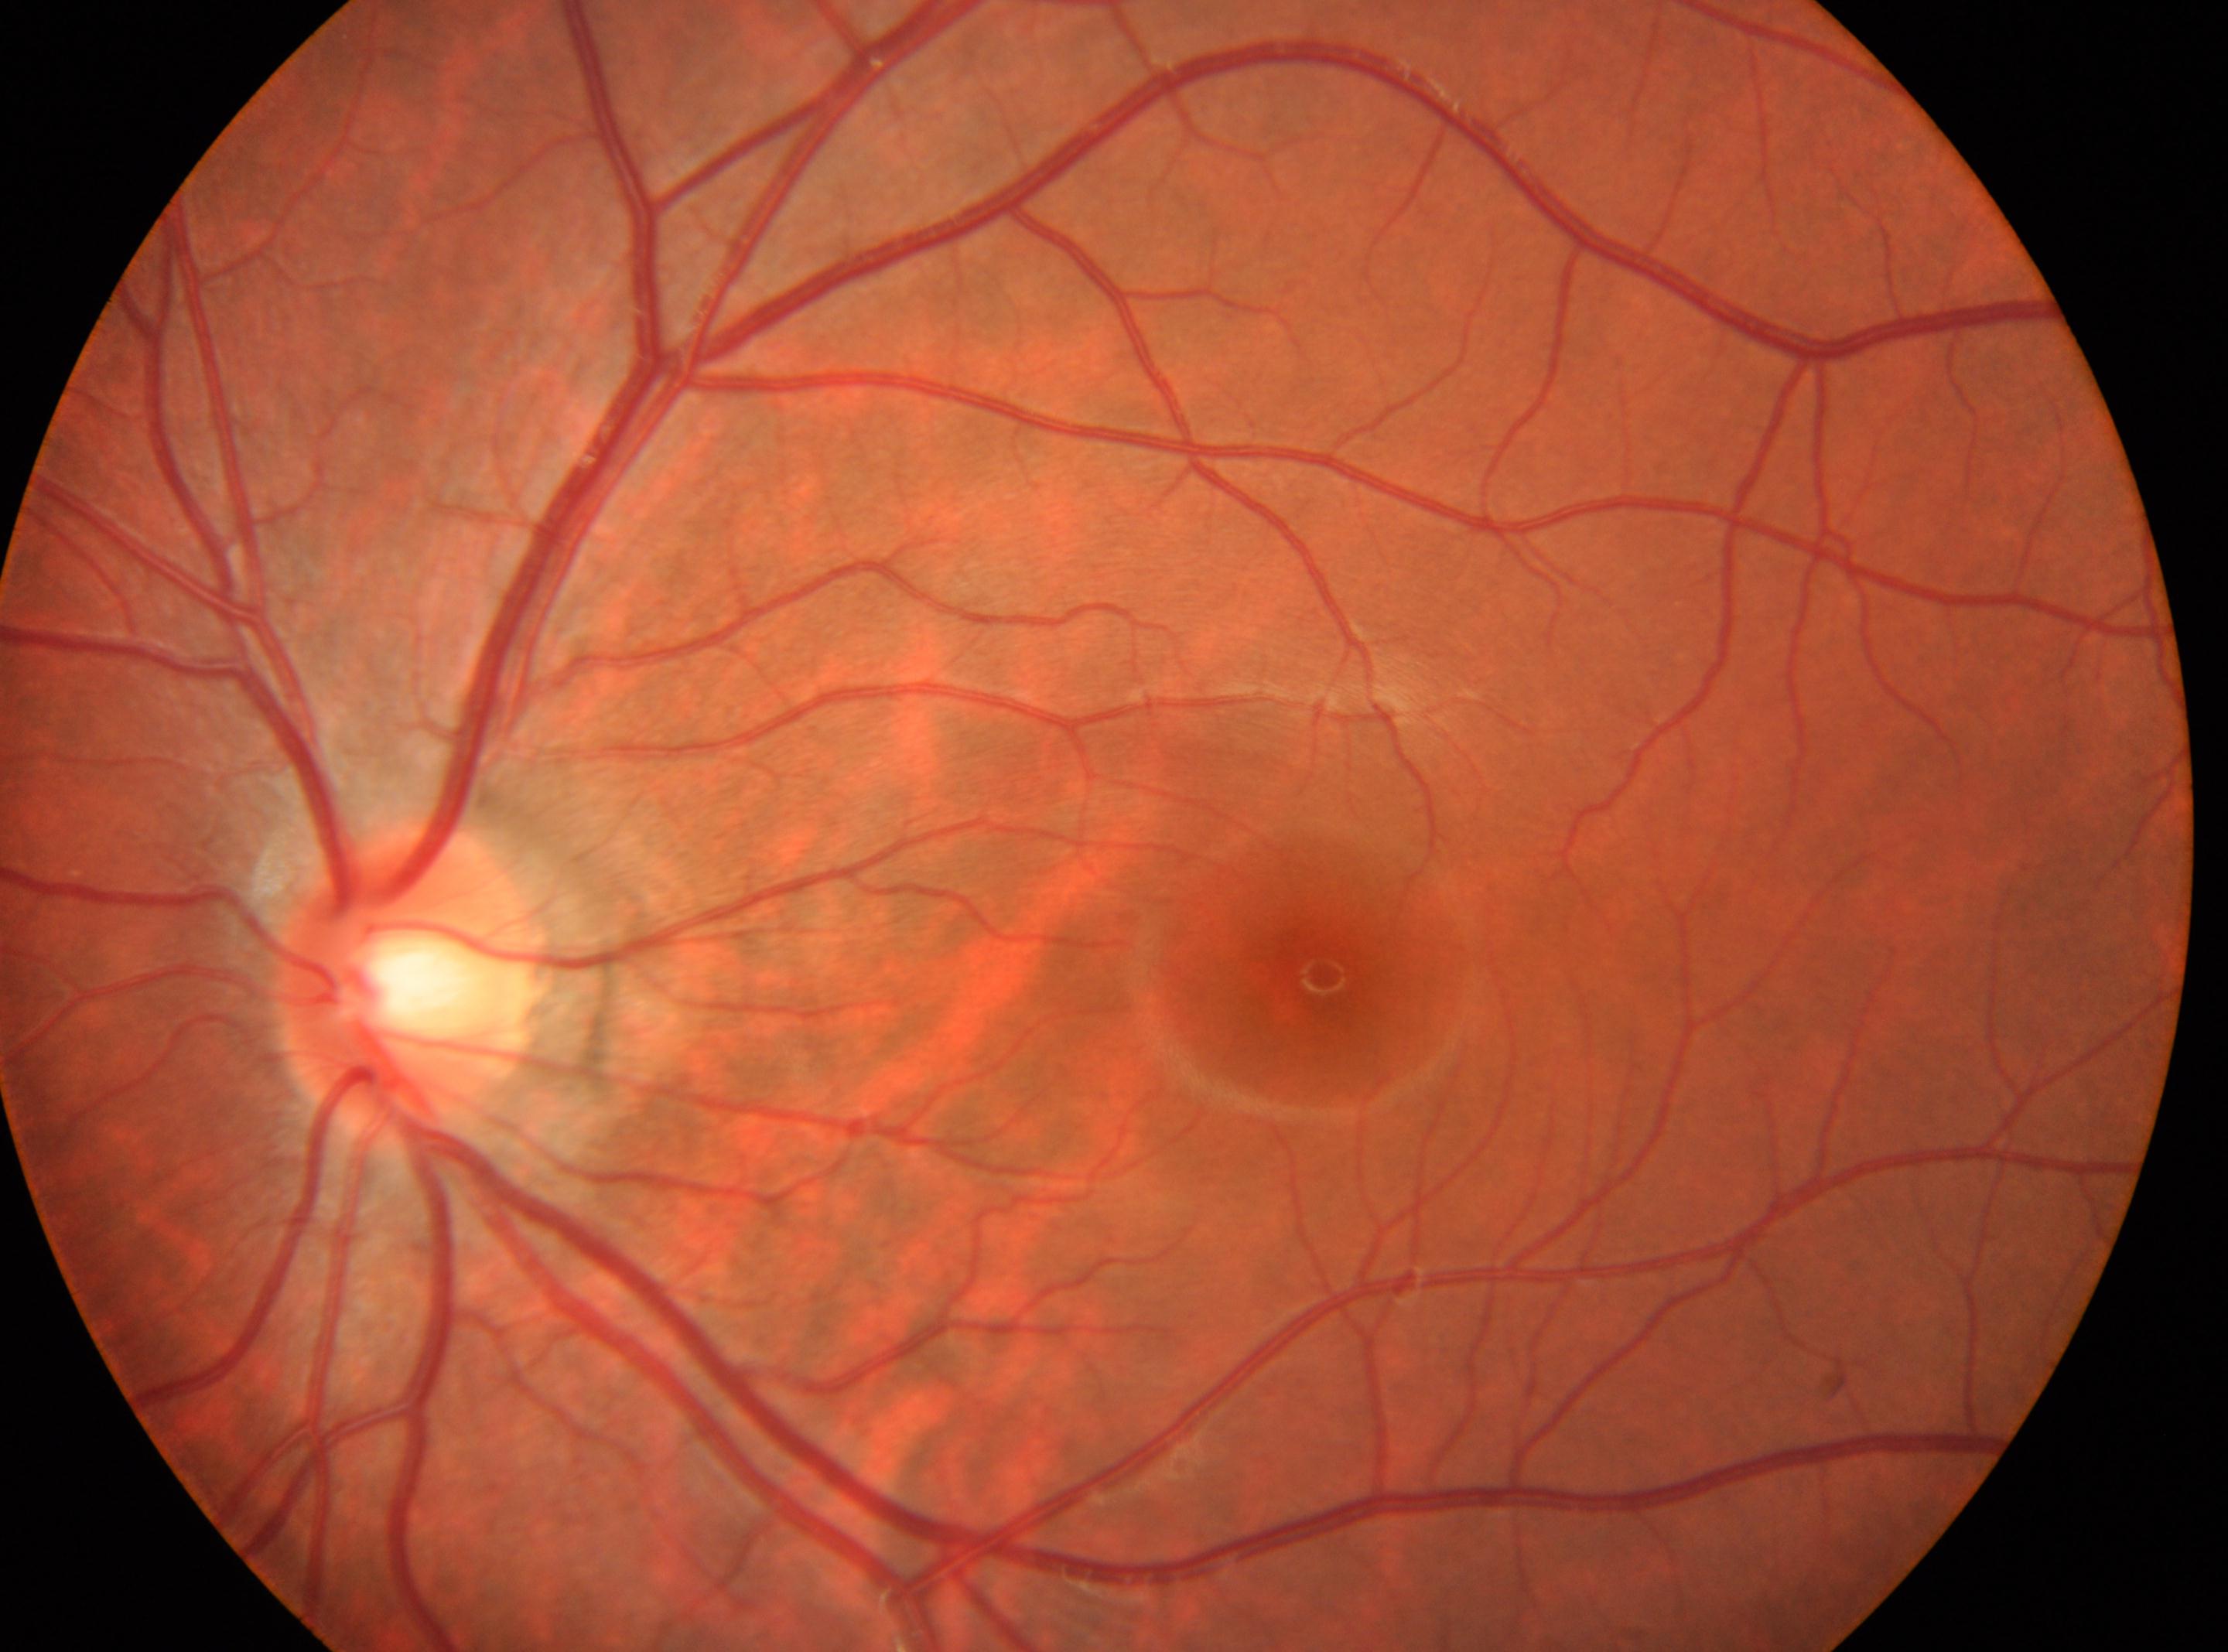

diabetic retinopathy (DR): no apparent retinopathy (grade 0) | laterality: left eye | DR impression: No diabetic retinopathy identified | disc center: (407, 985) | macula center: (1323, 974).